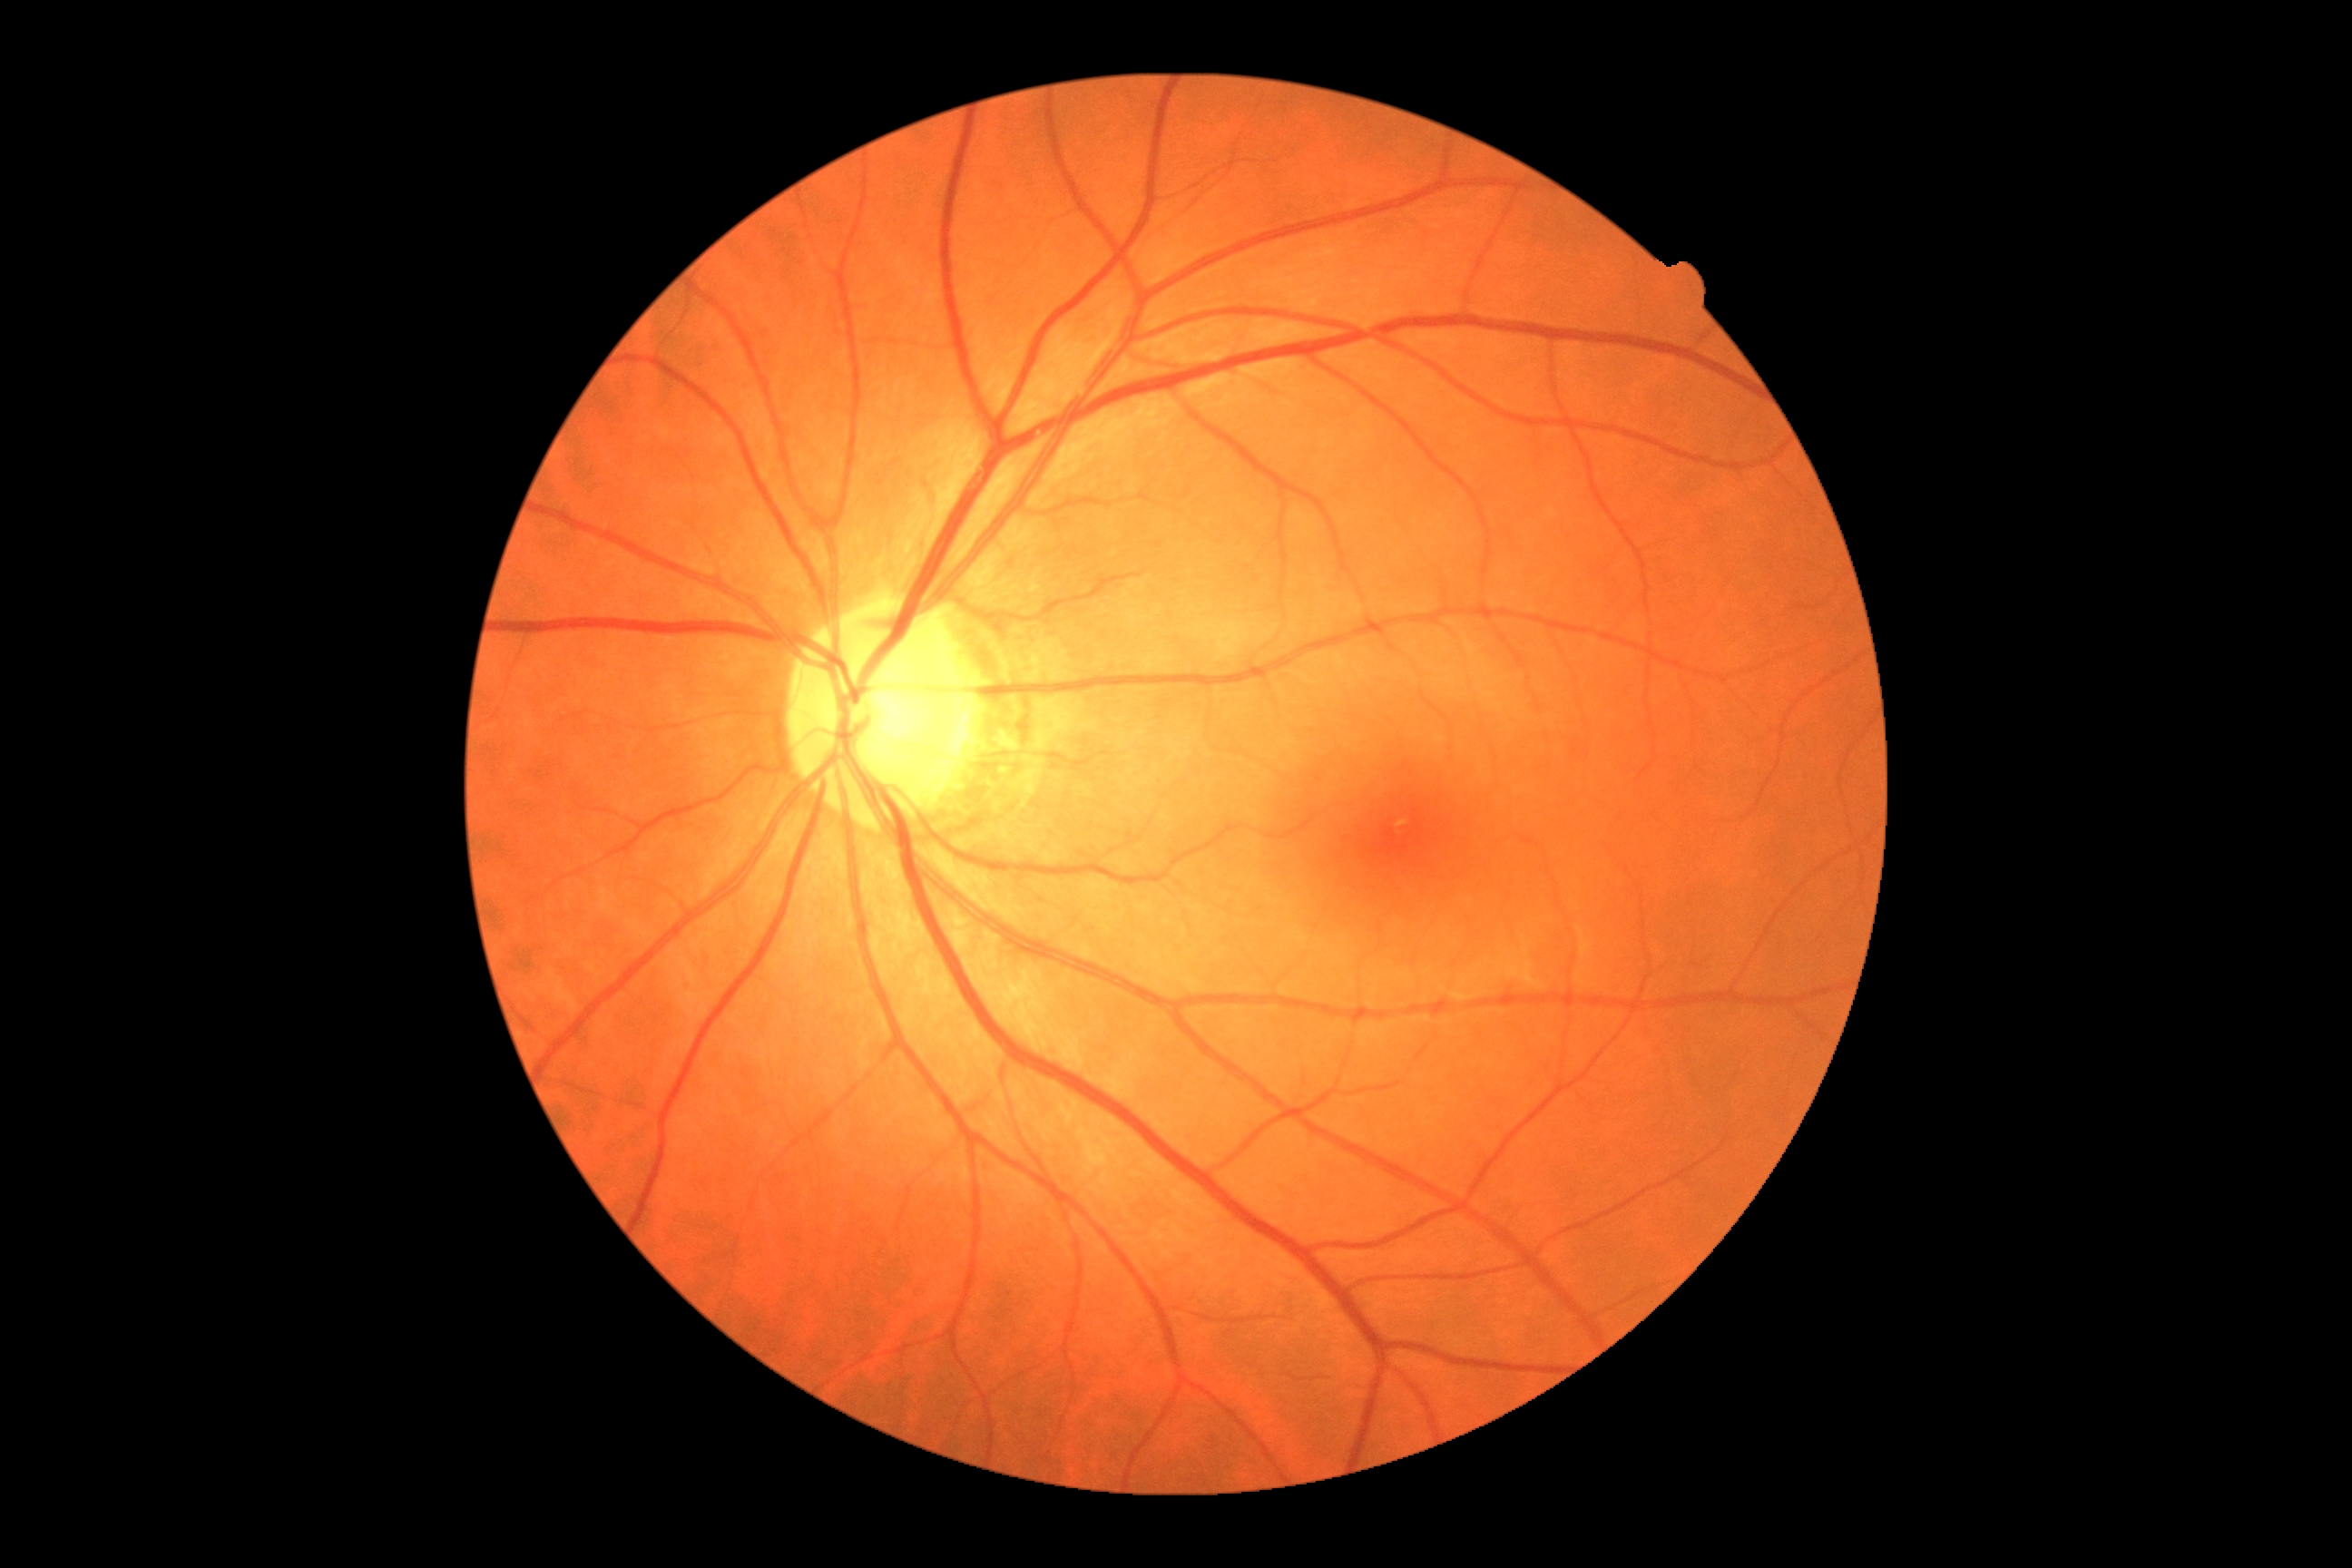 DR: grade 0 (no apparent retinopathy) — no visible signs of diabetic retinopathy.